1932x1916px
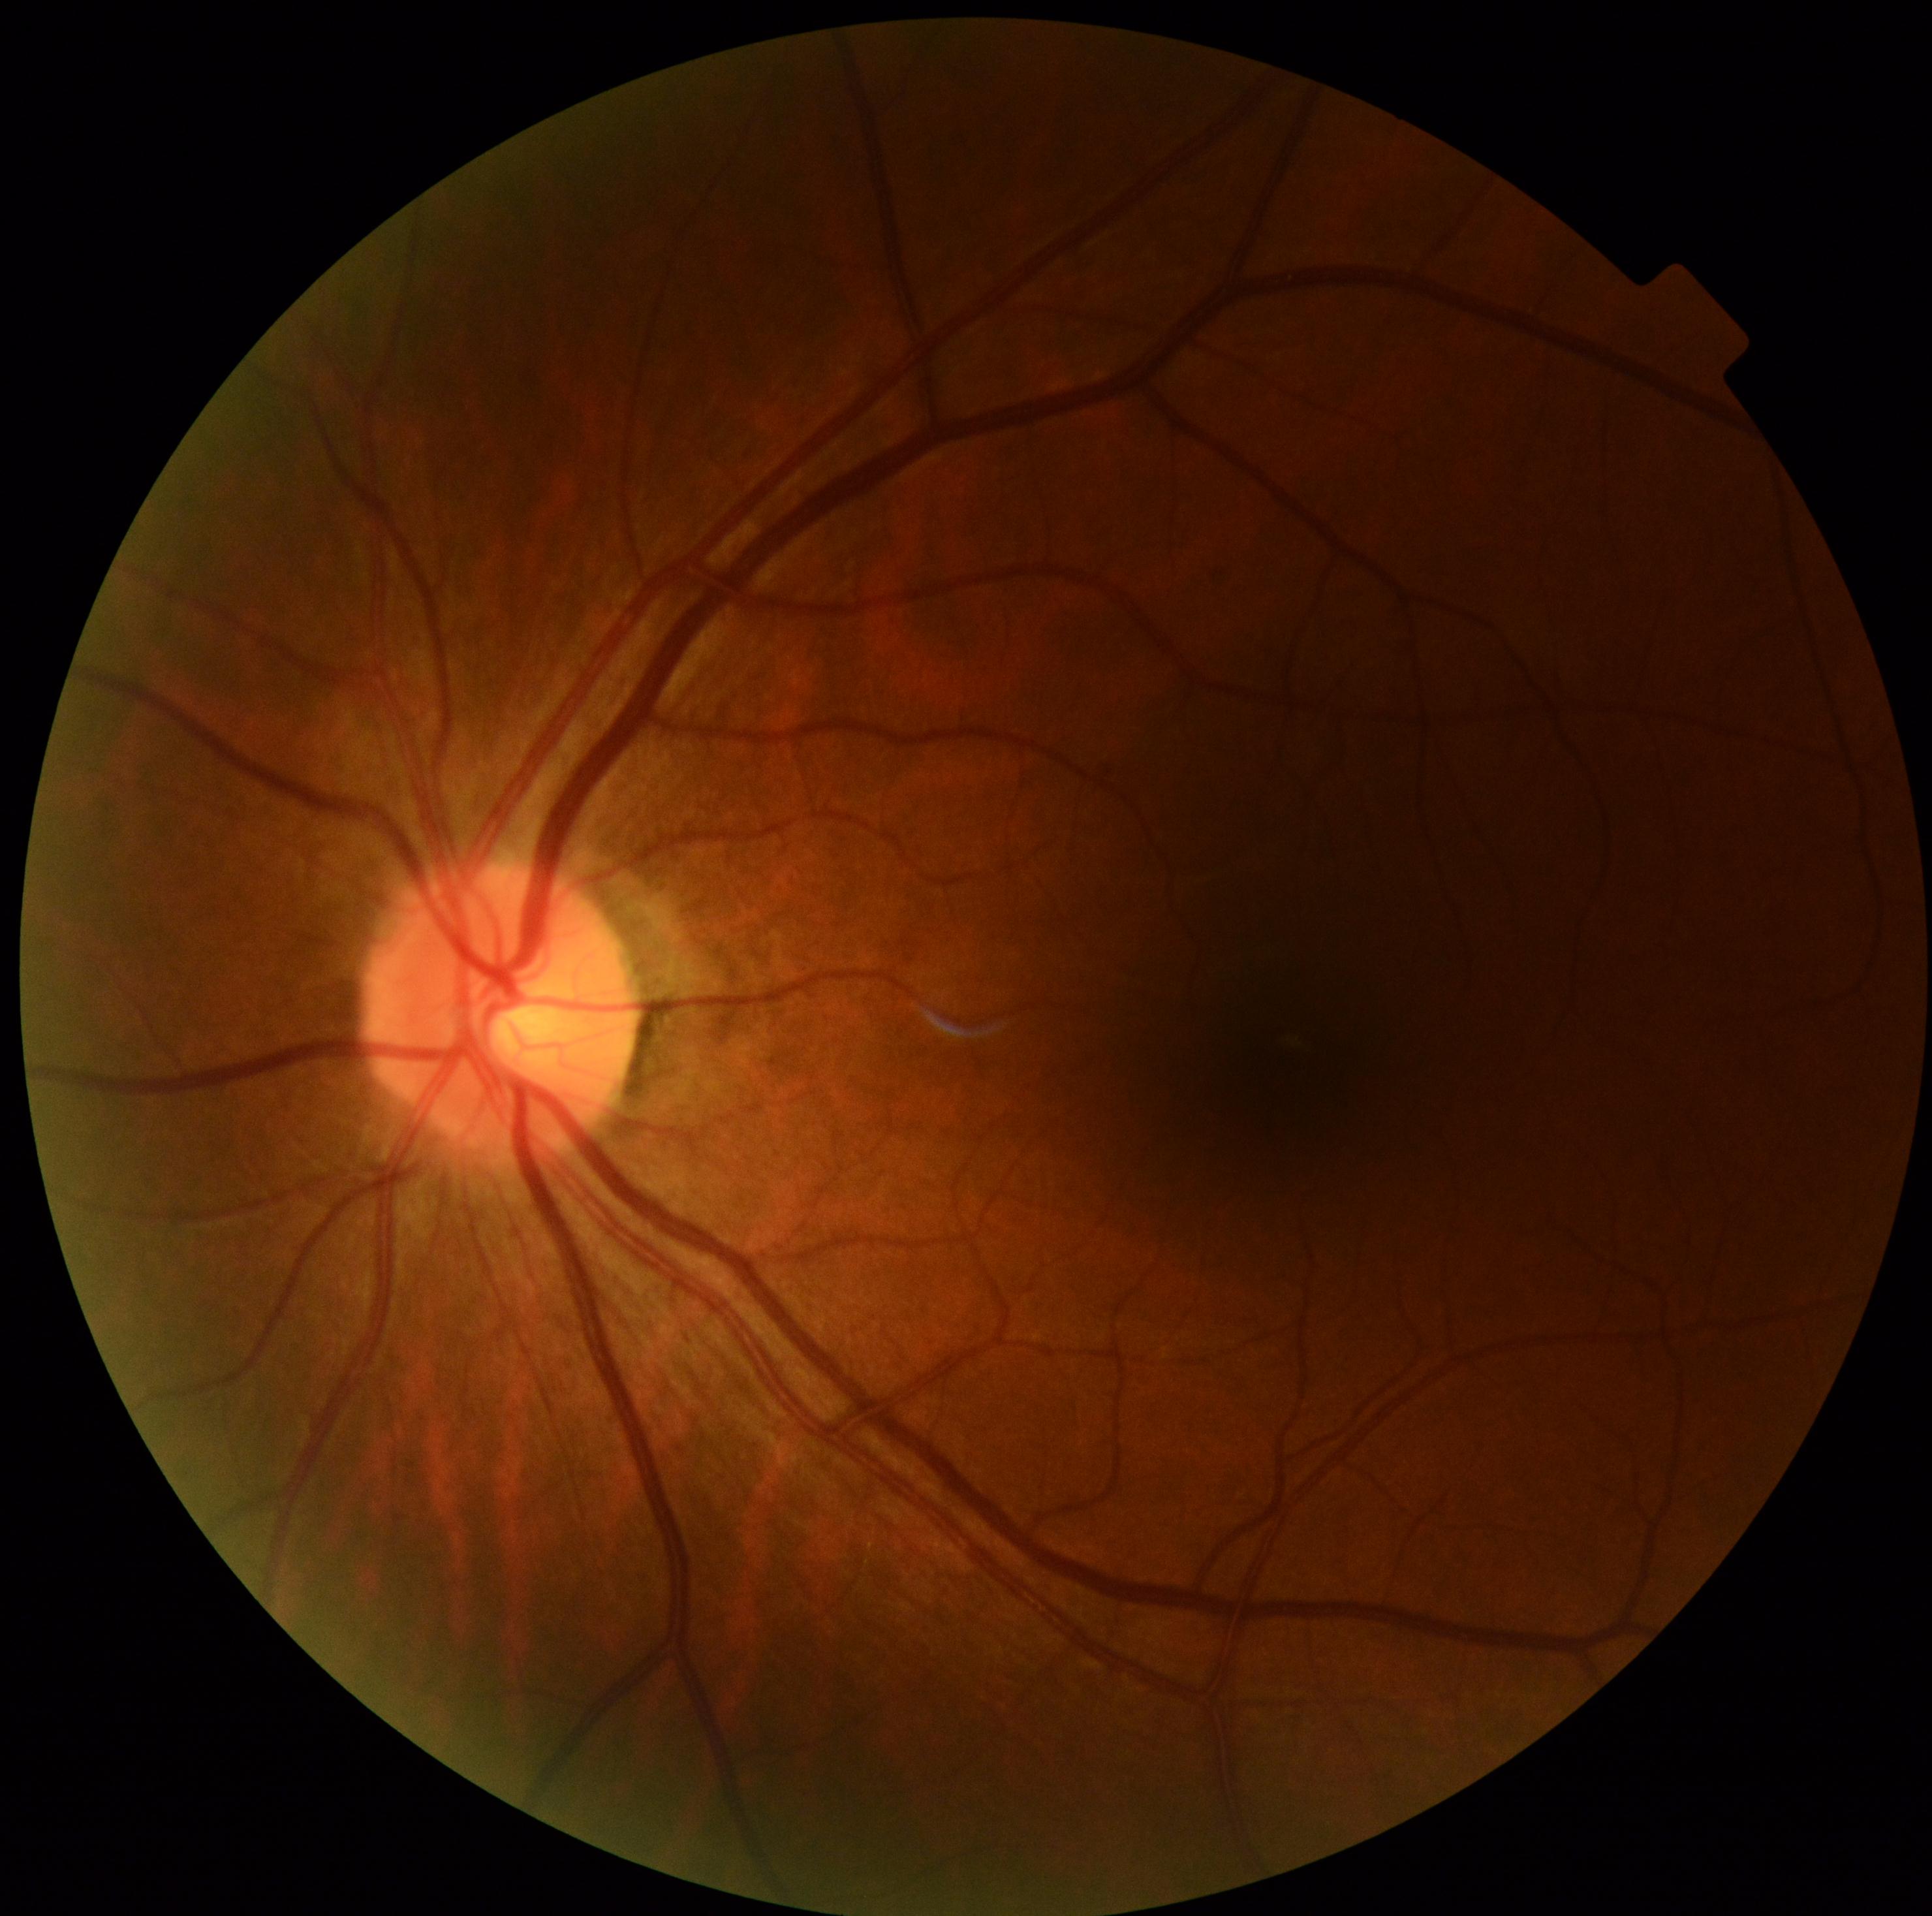

Retinopathy is grade 0 (no apparent retinopathy).